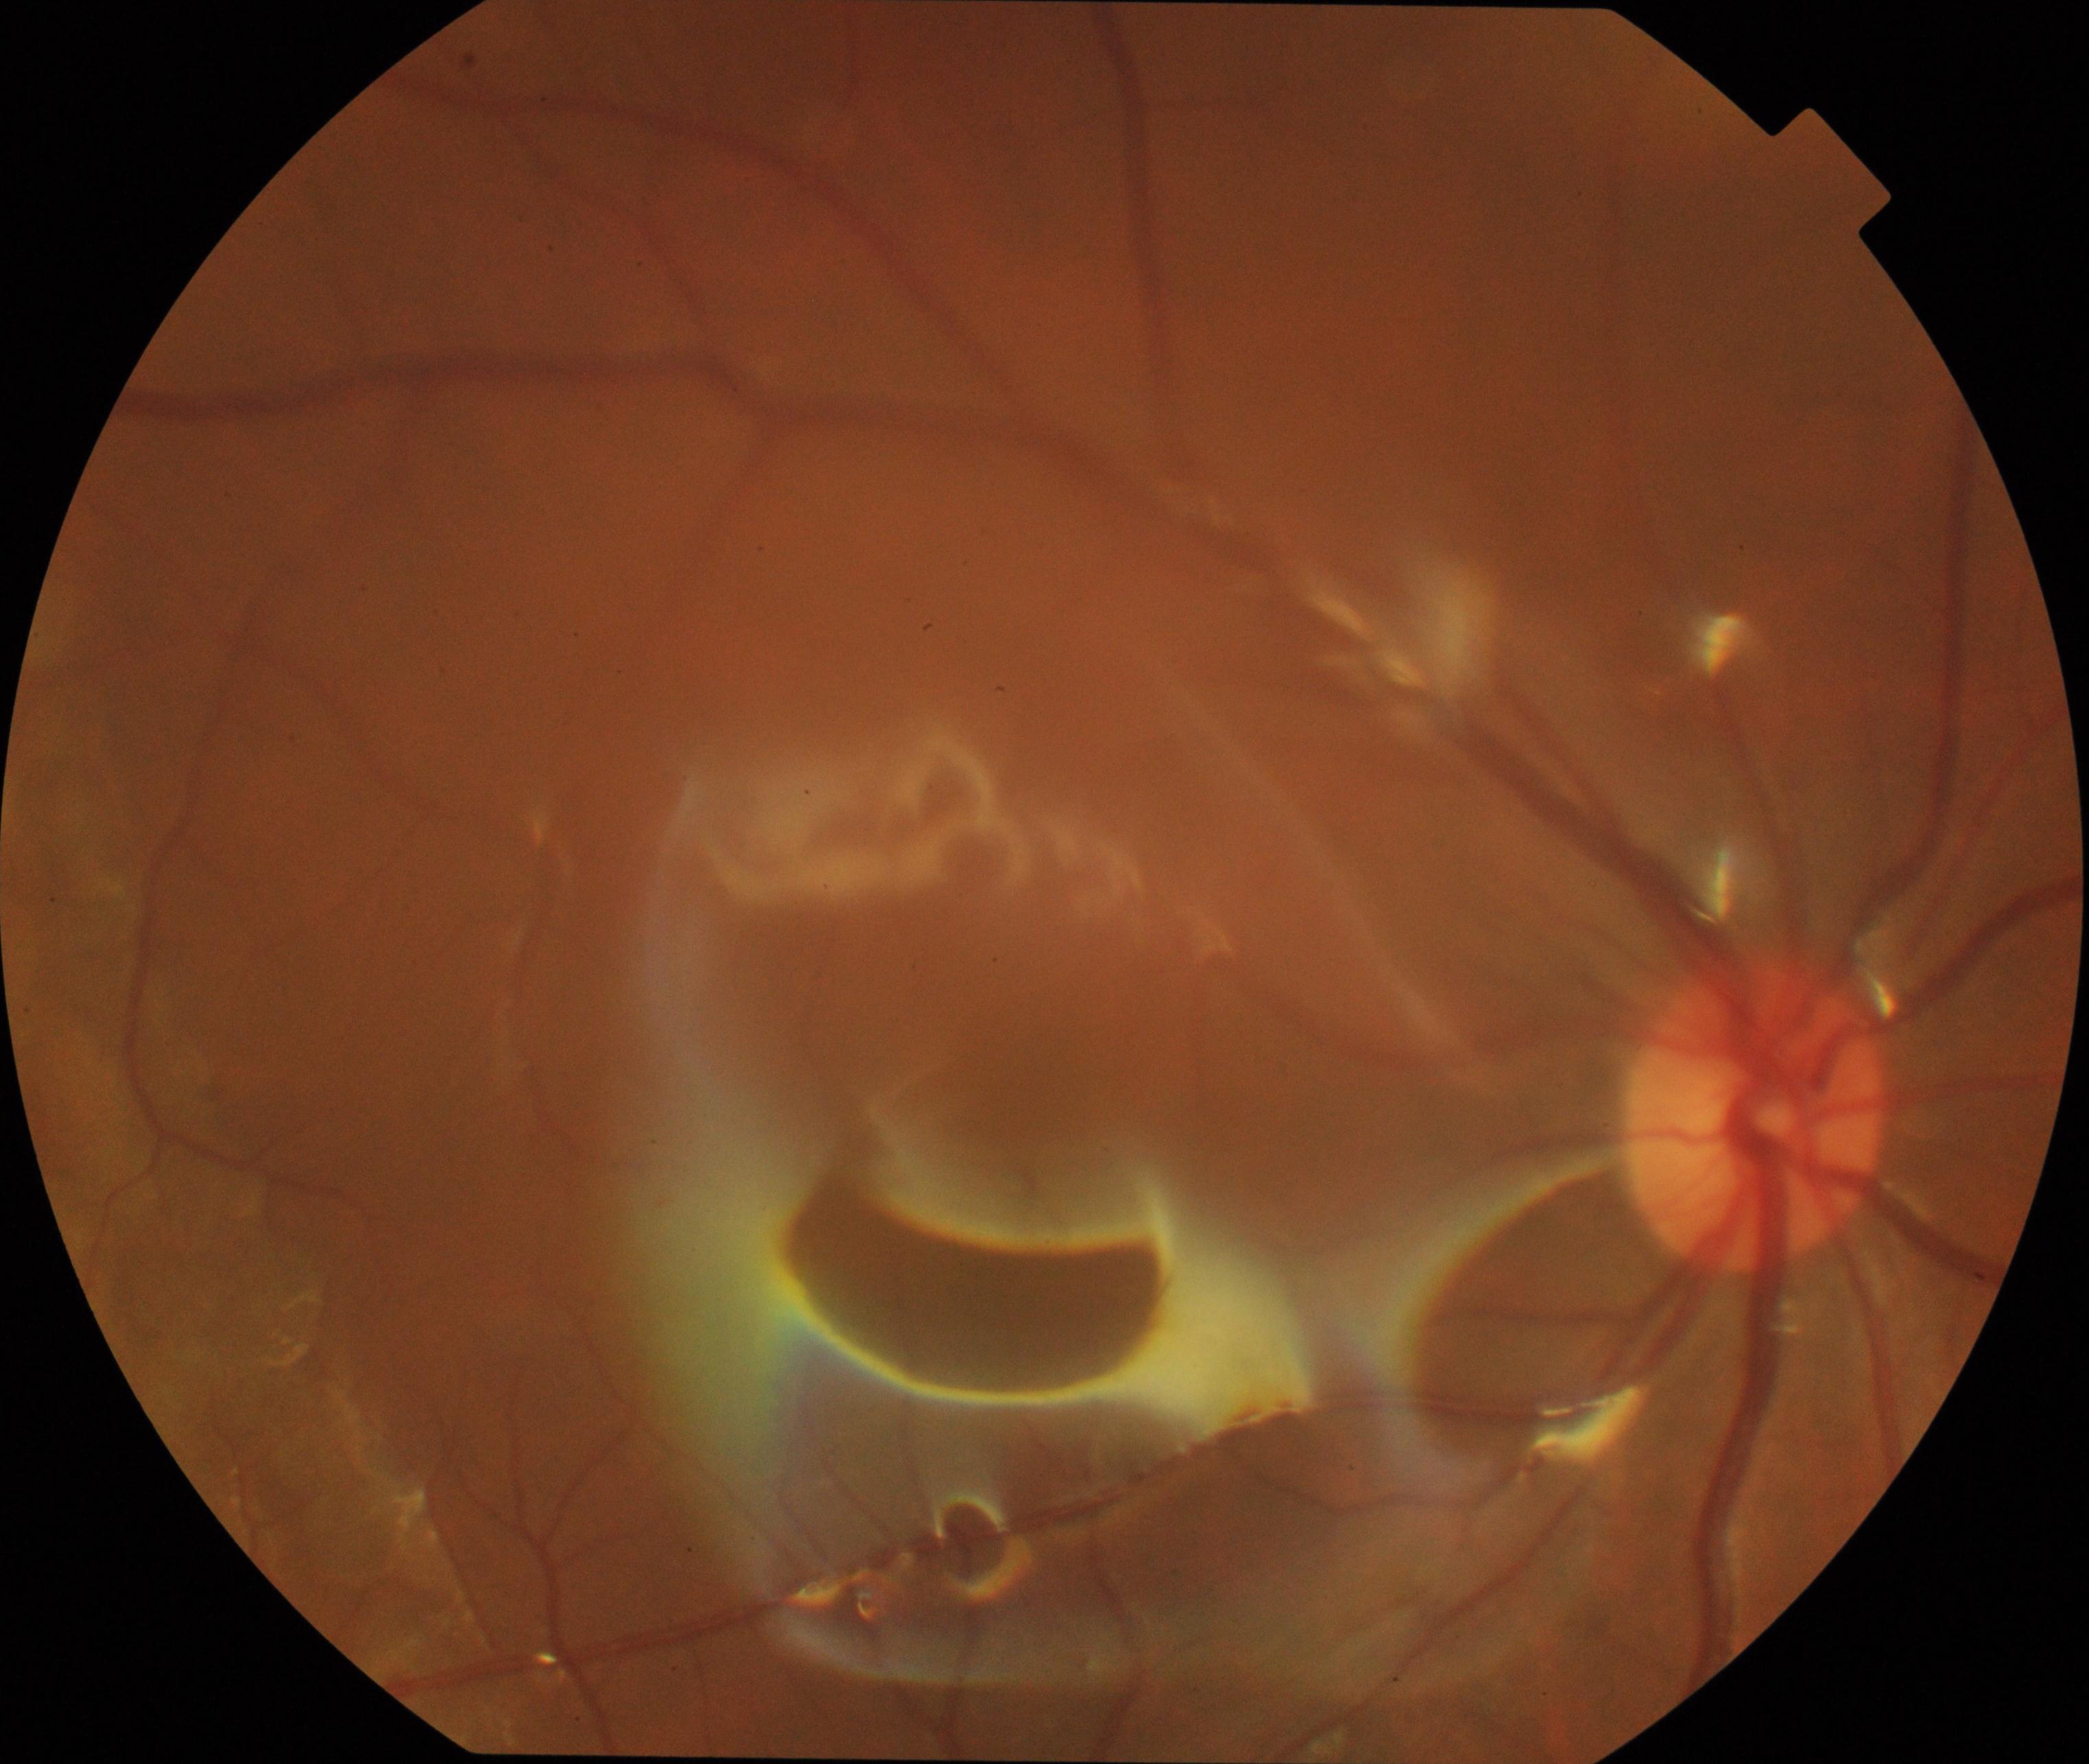

Findings: silicone oil in the eye.